CFP:
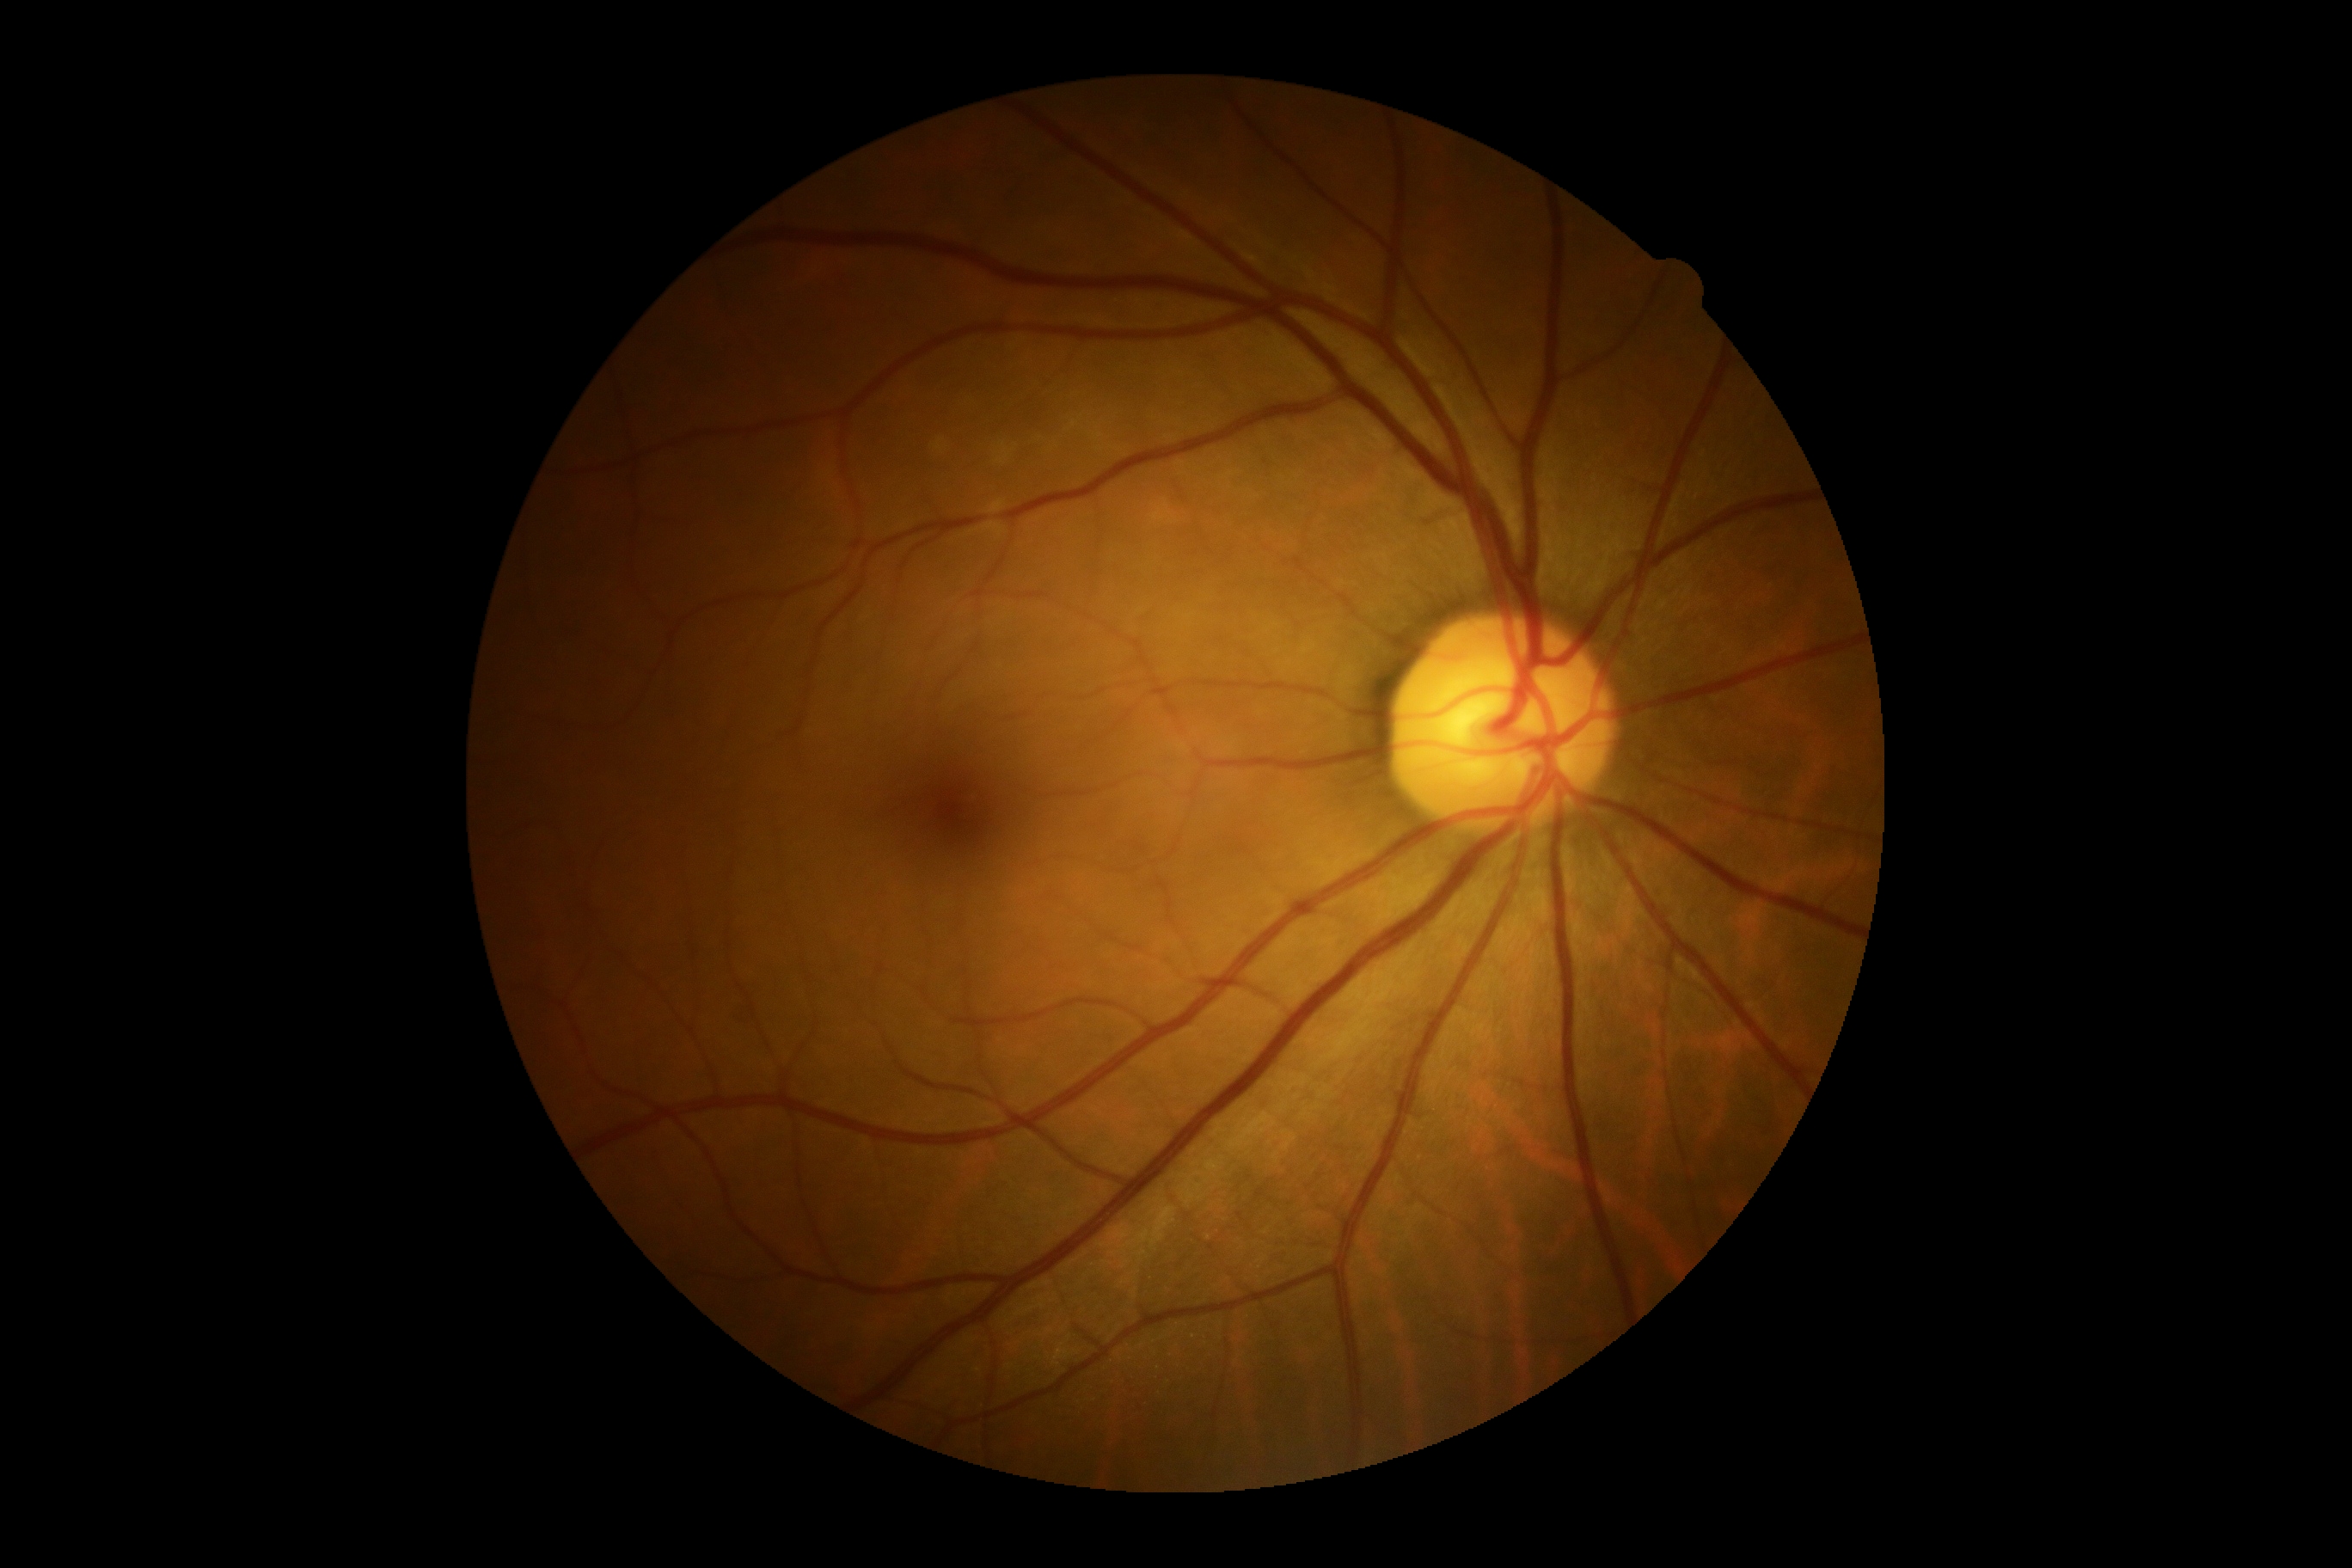

retinopathy: 0/4.